Wide-field contact fundus photograph of an infant:
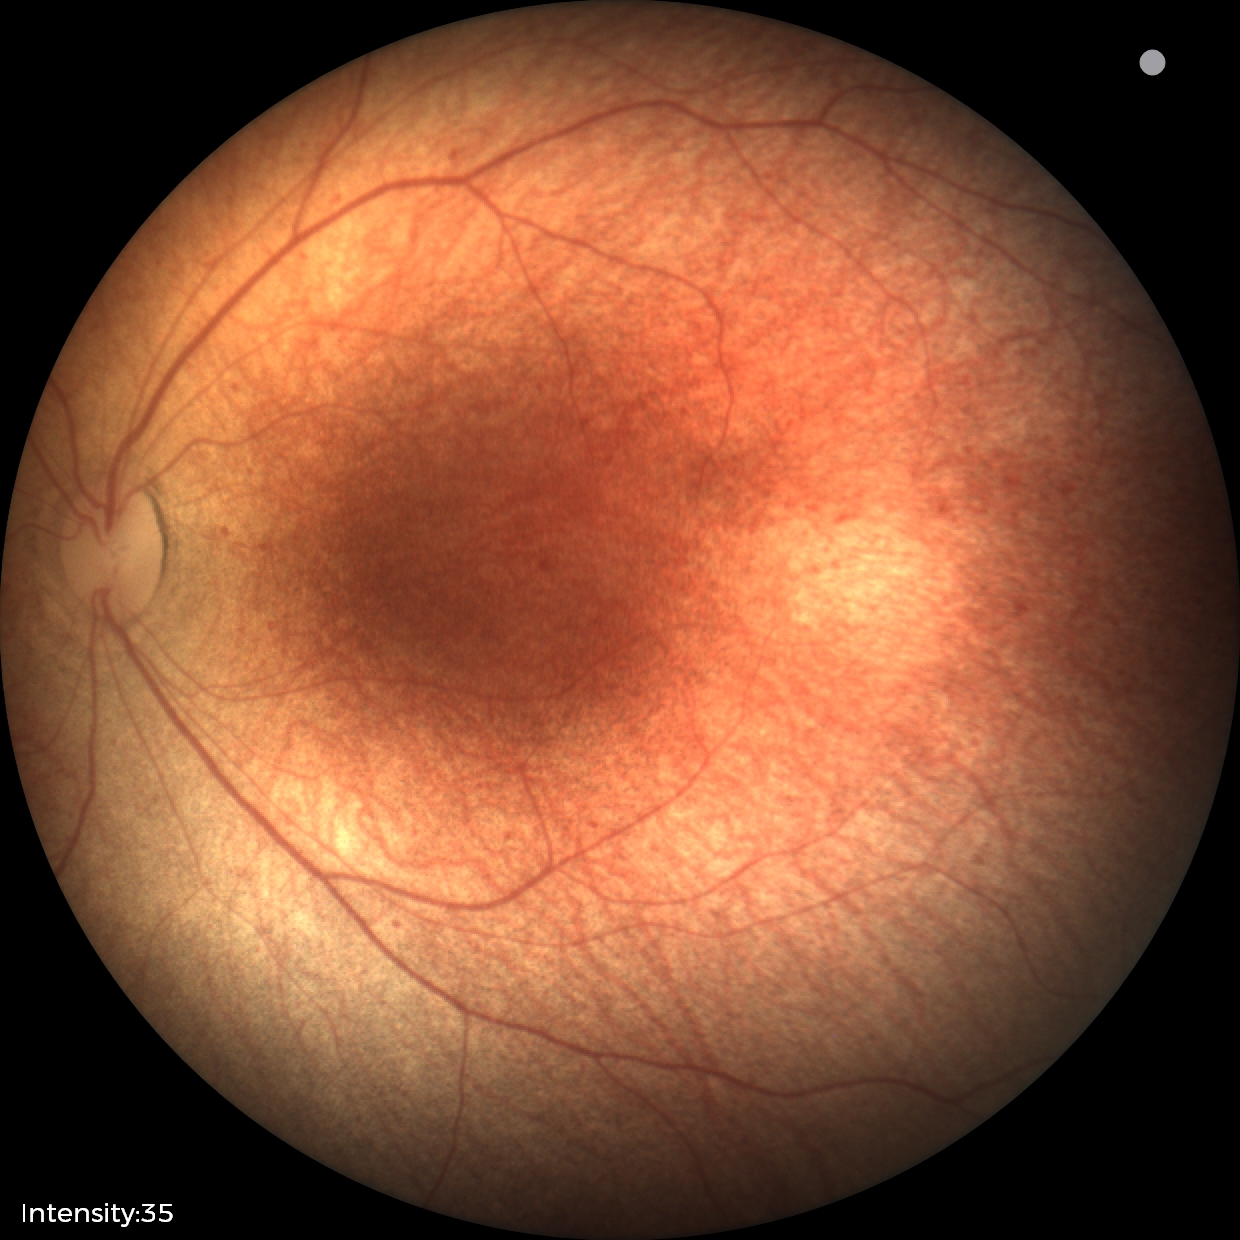

Screening examination diagnosed as physiological.